Image size 1932x1932
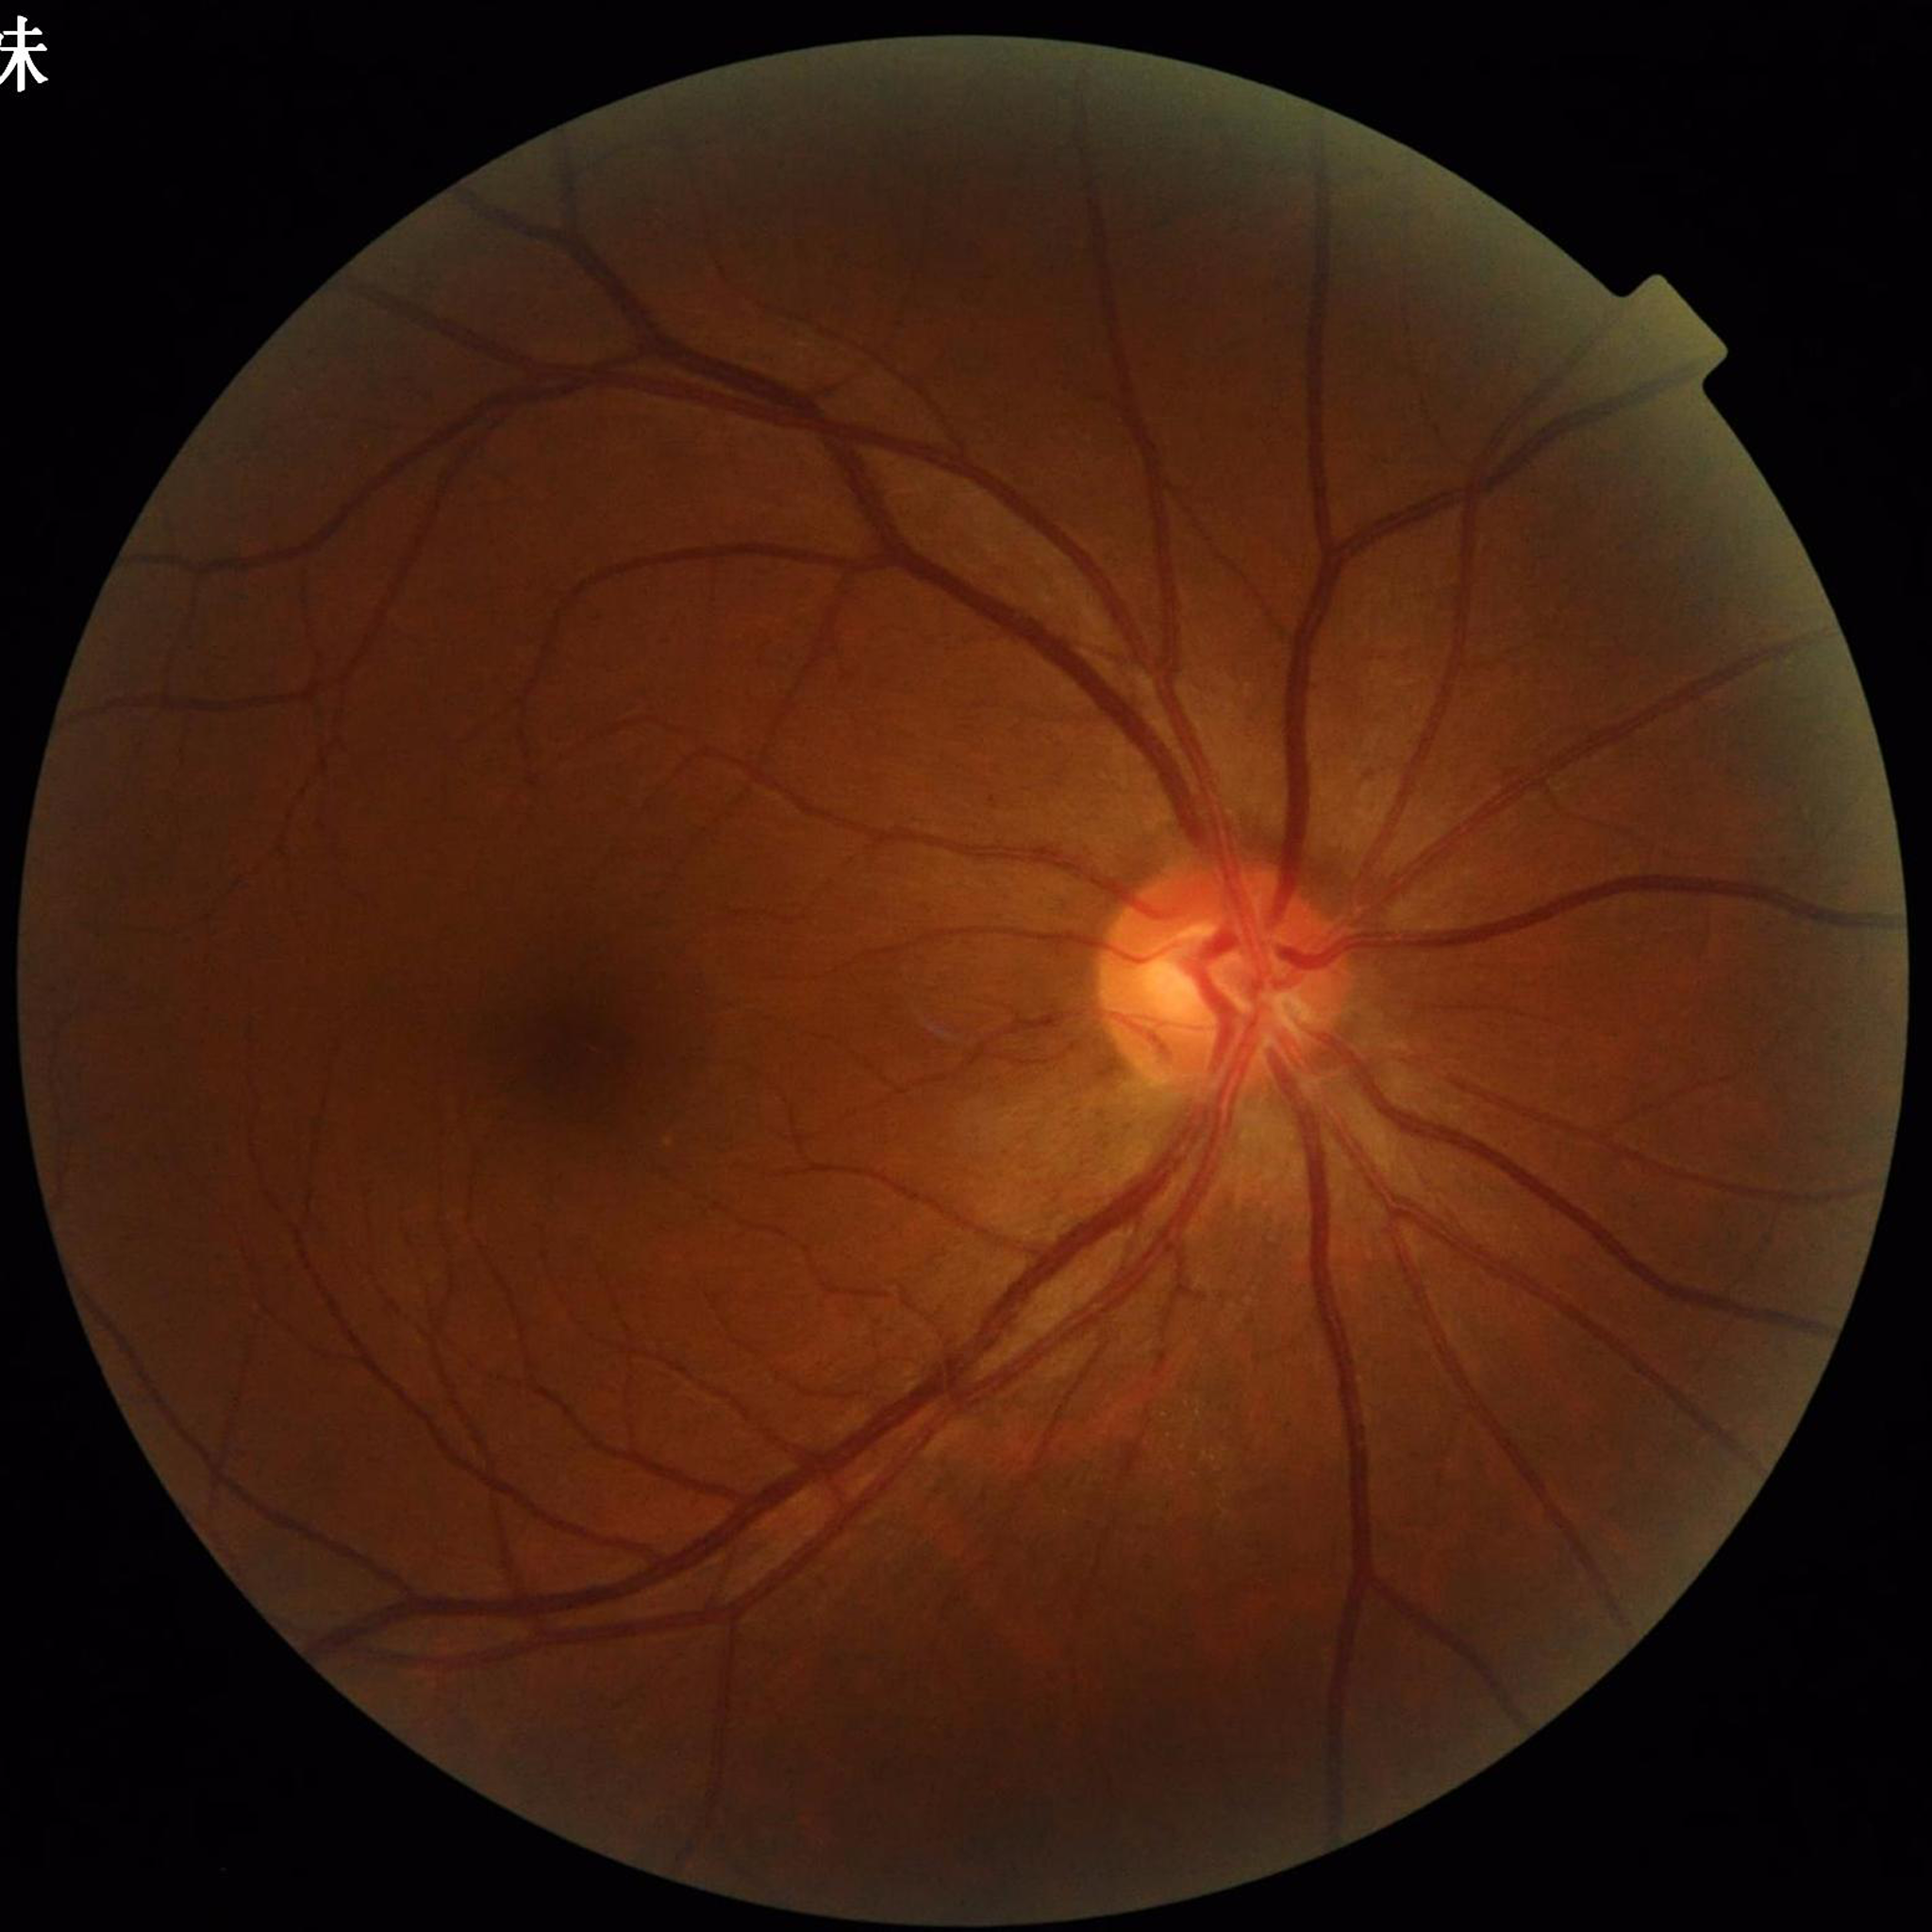

Impression: glaucoma; Automated quality assessment: good.